Modified Davis grading:
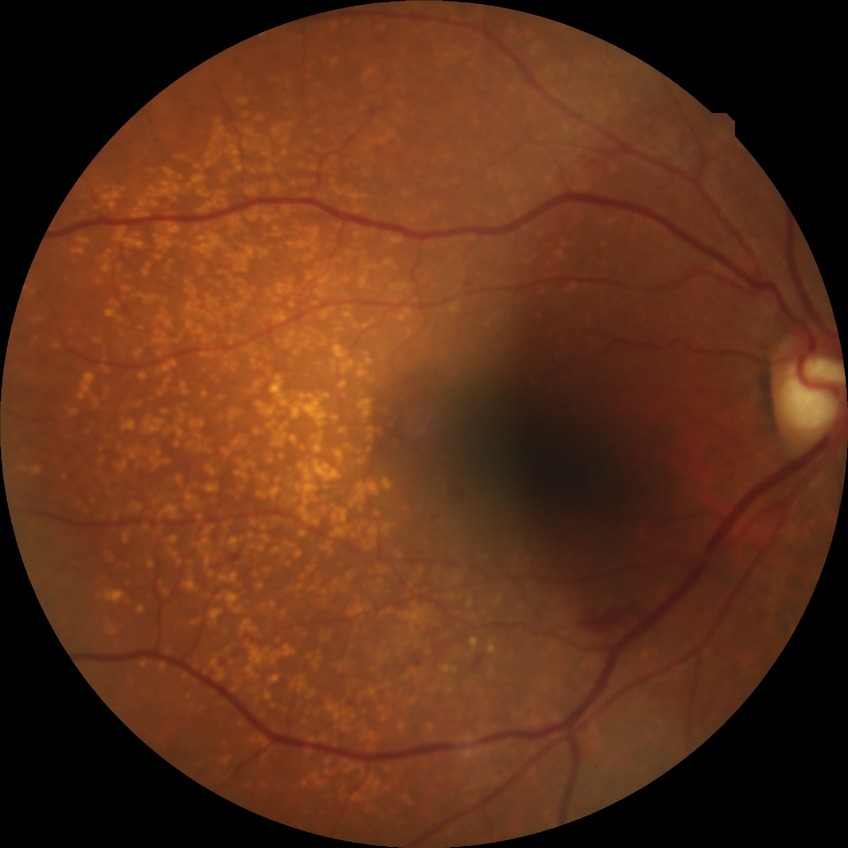

Modified Davis grading is simple diabetic retinopathy.